Modified Davis classification — 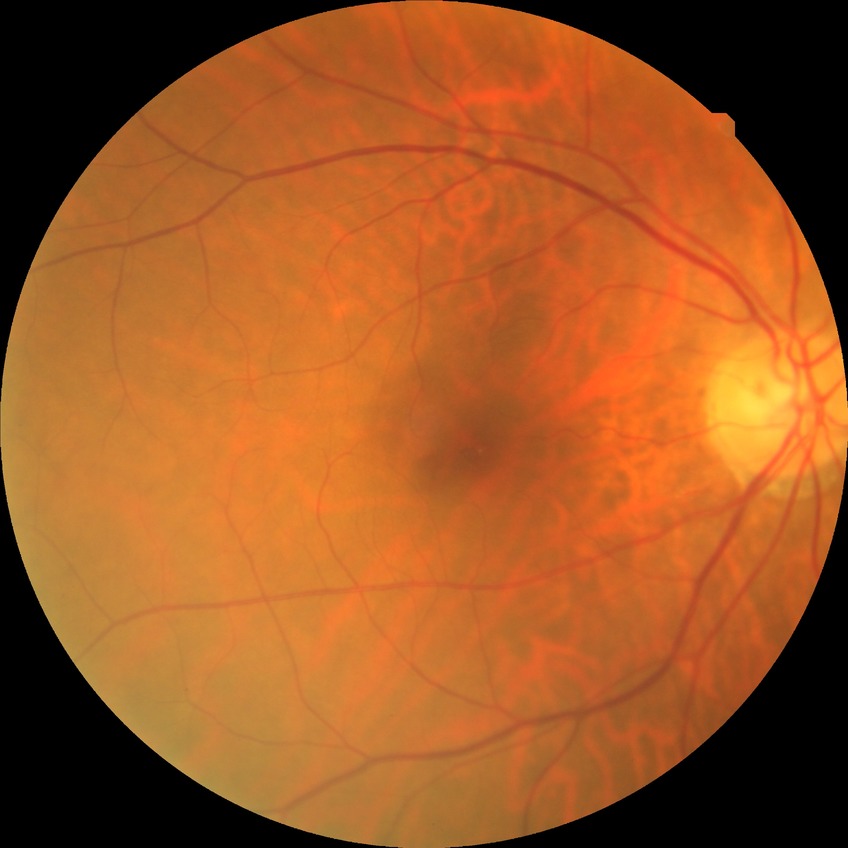 DR impression: negative for DR; Davis grade: NDR.